Camera: Topcon TRC-50DX:
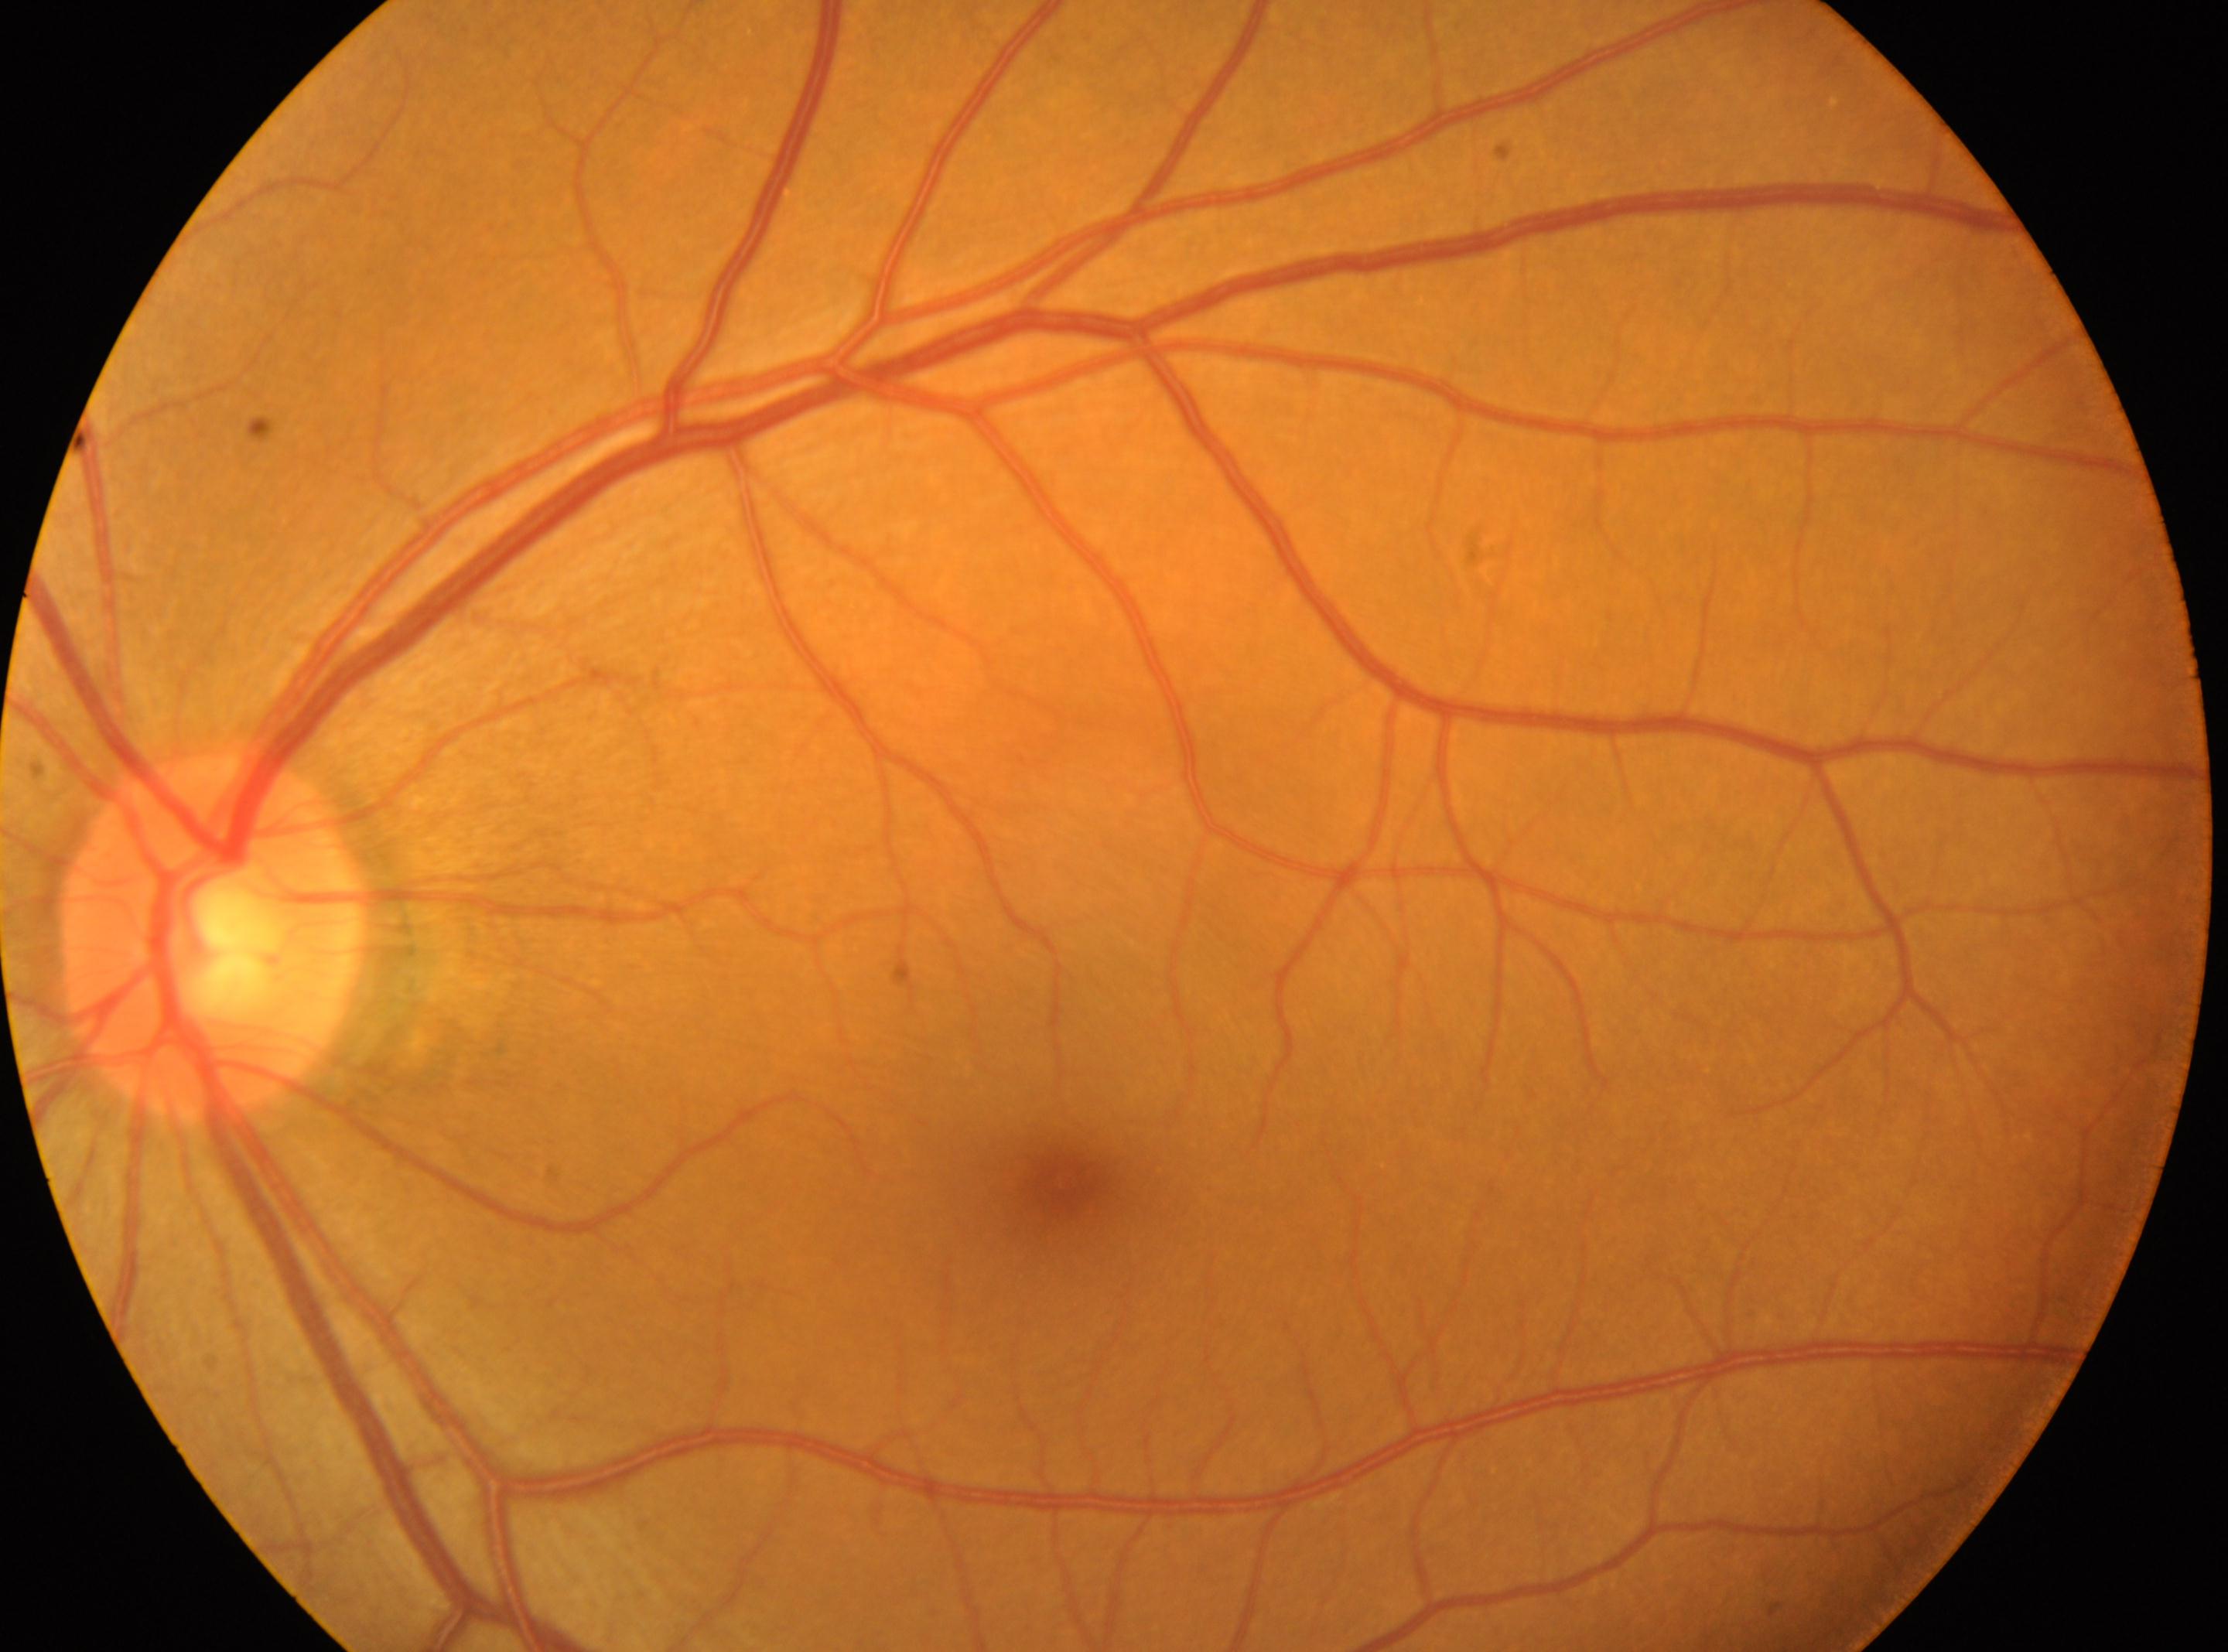 Annotations:
* DR impression · No diabetic retinal disease findings
* foveal center · x=1064, y=1186
* diabetic retinopathy (DR) · grade 0 (no apparent retinopathy)
* optic disc center · x=214, y=937
* laterality · left eye